No pharmacologic dilation · color fundus image · acquired with a NIDEK AFC-230 · 848x848px · 45-degree field of view:
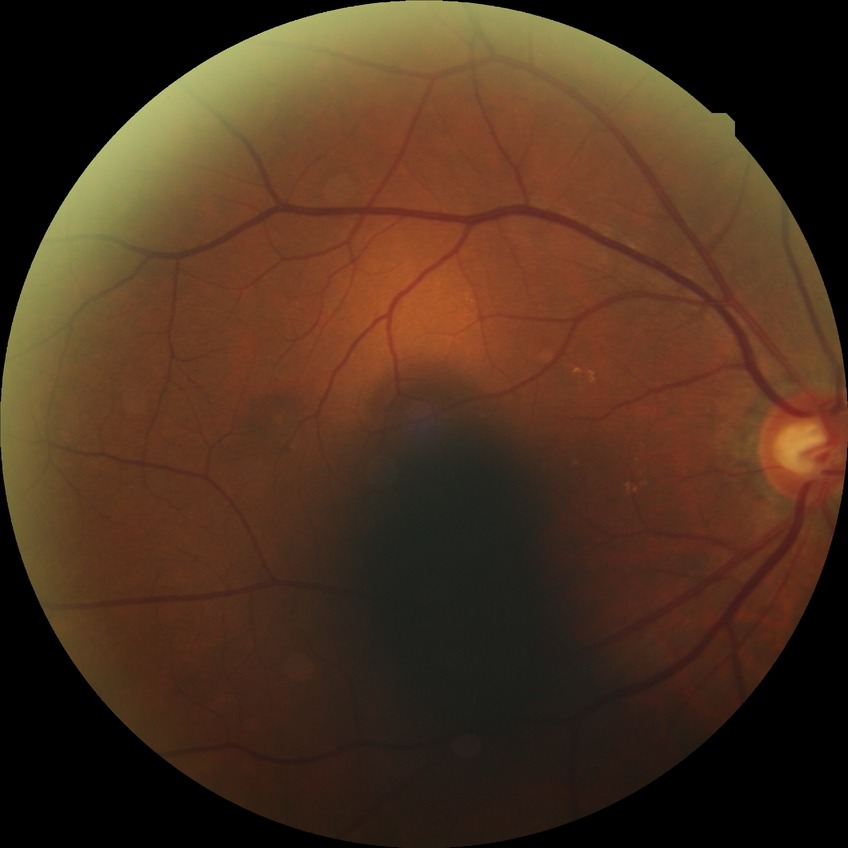
Diabetic retinopathy (DR): no diabetic retinopathy (NDR).